FOV: 60 degrees, portable fundus photograph:
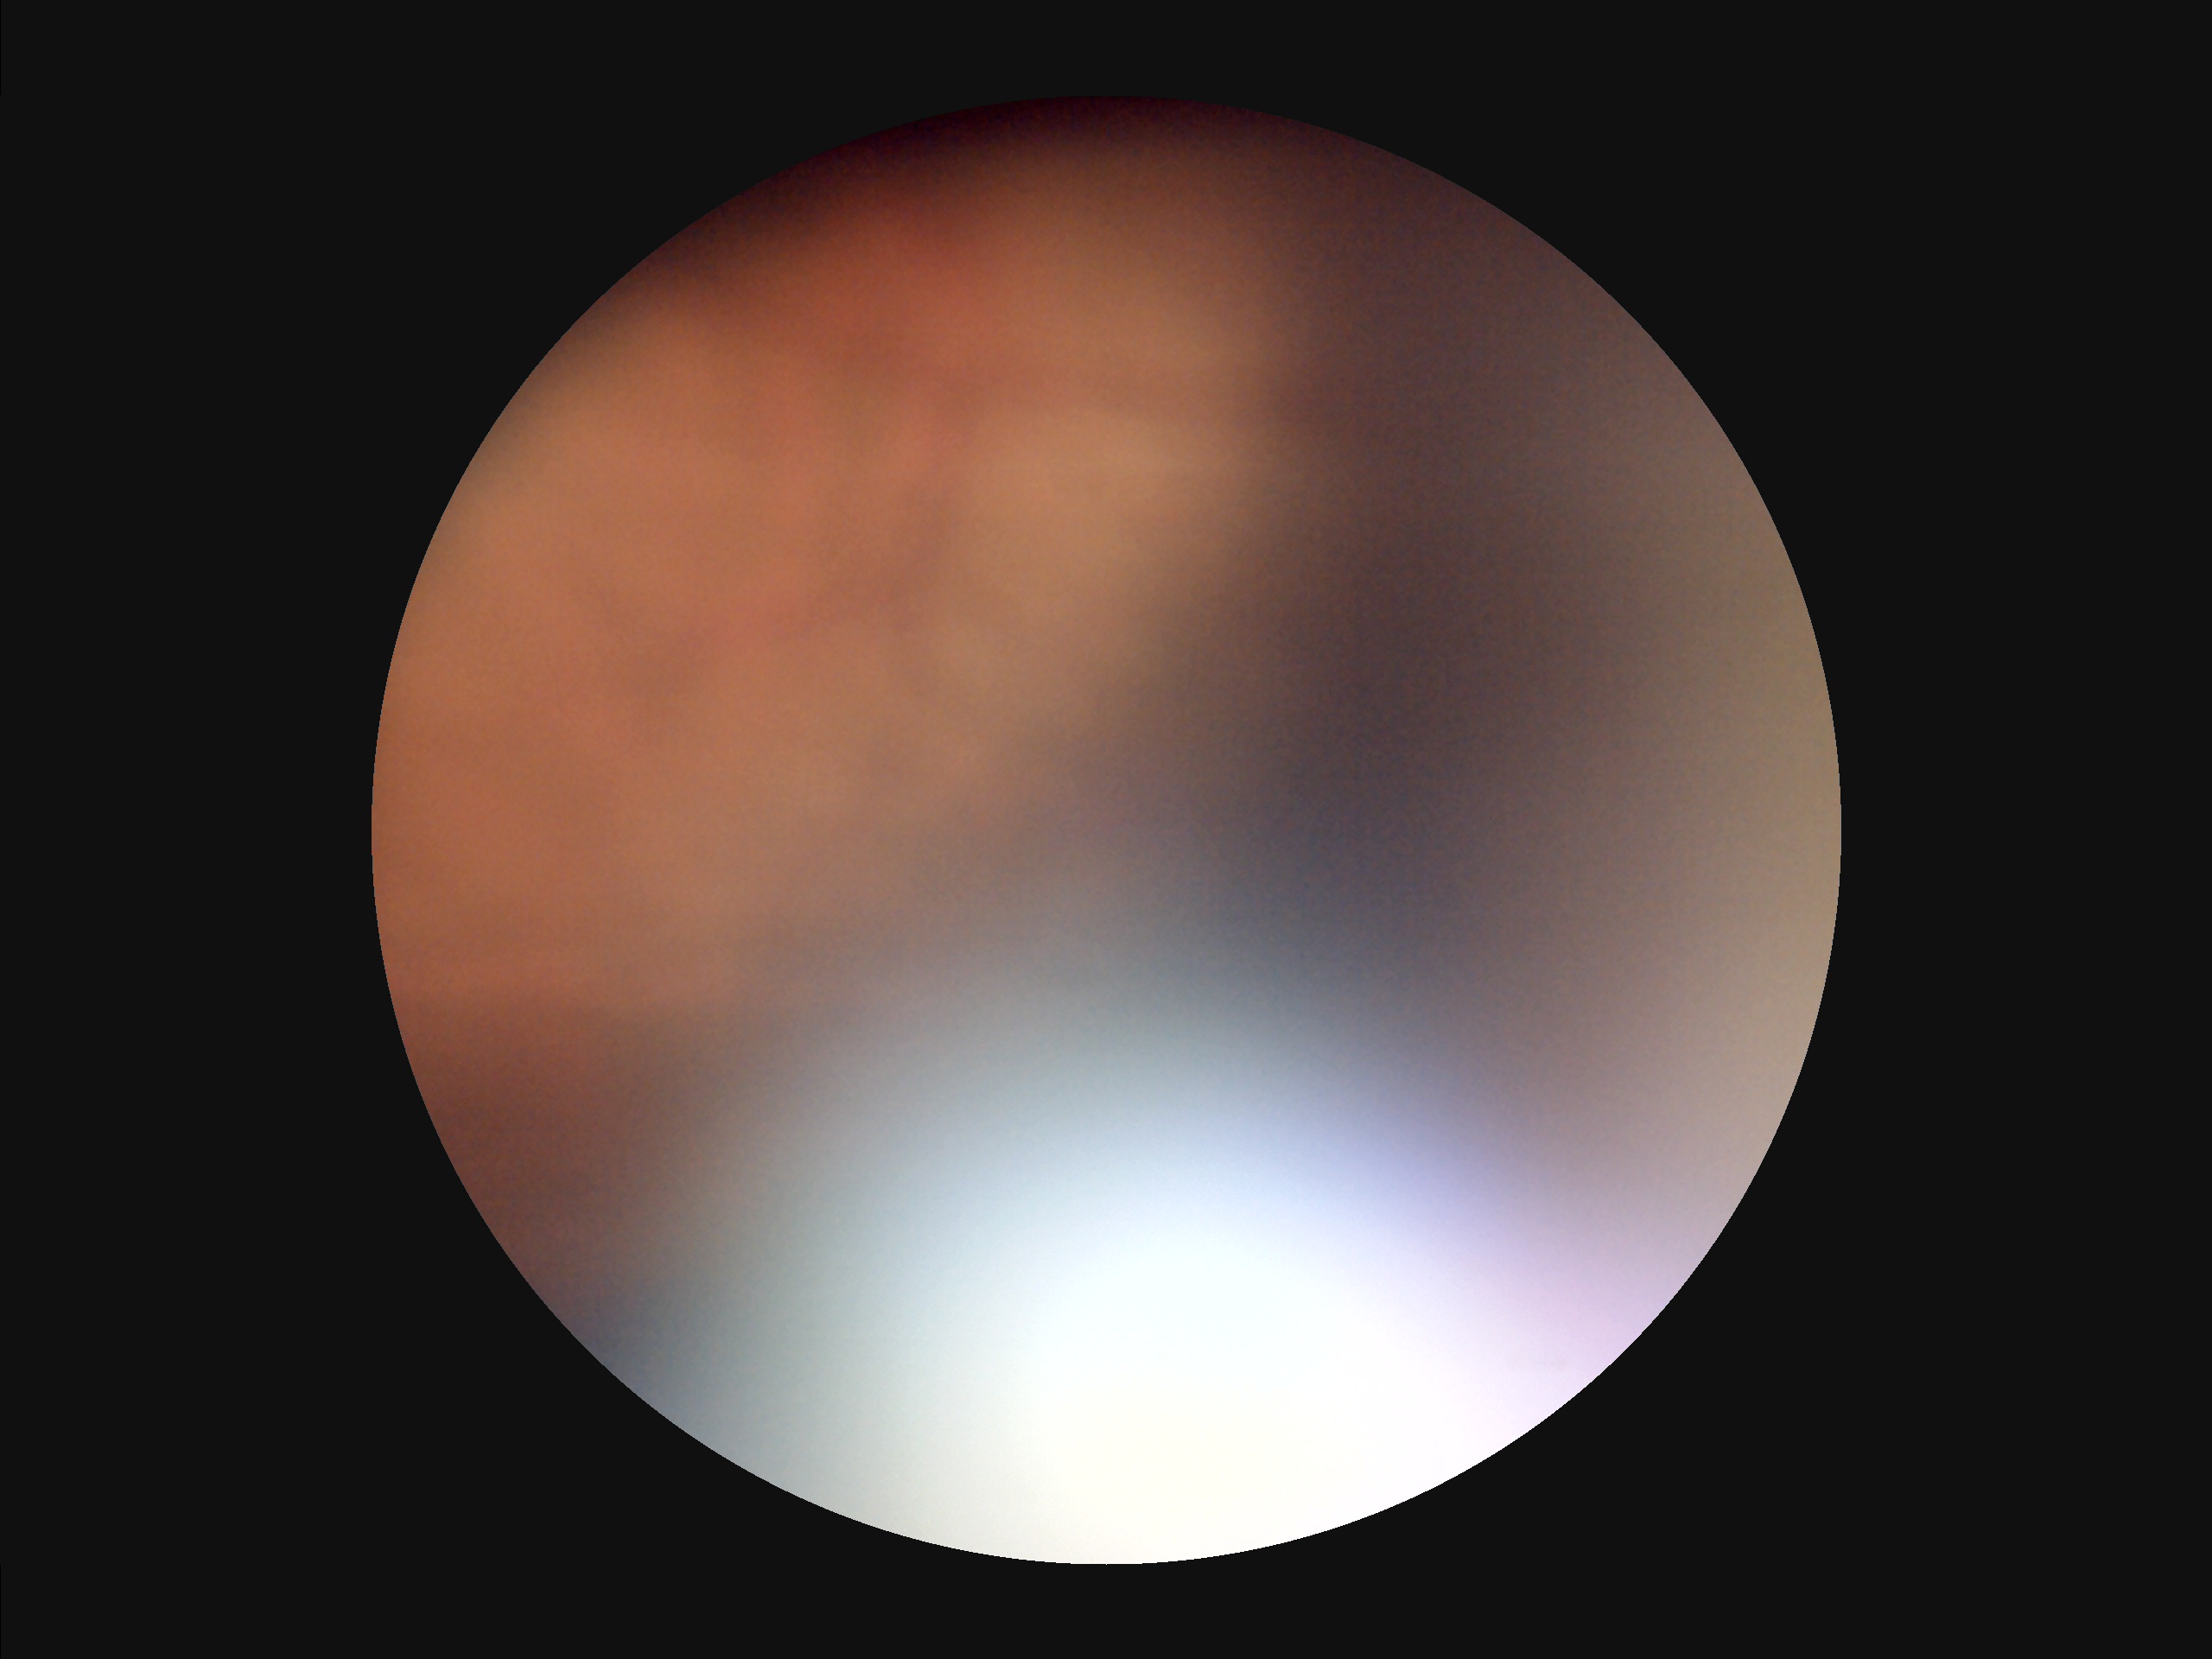

There is over- or under-exposure or a color cast.
Reduced sharpness with visible blur.
Image quality is suboptimal.
Poor dynamic range.